Retinal fundus photograph.
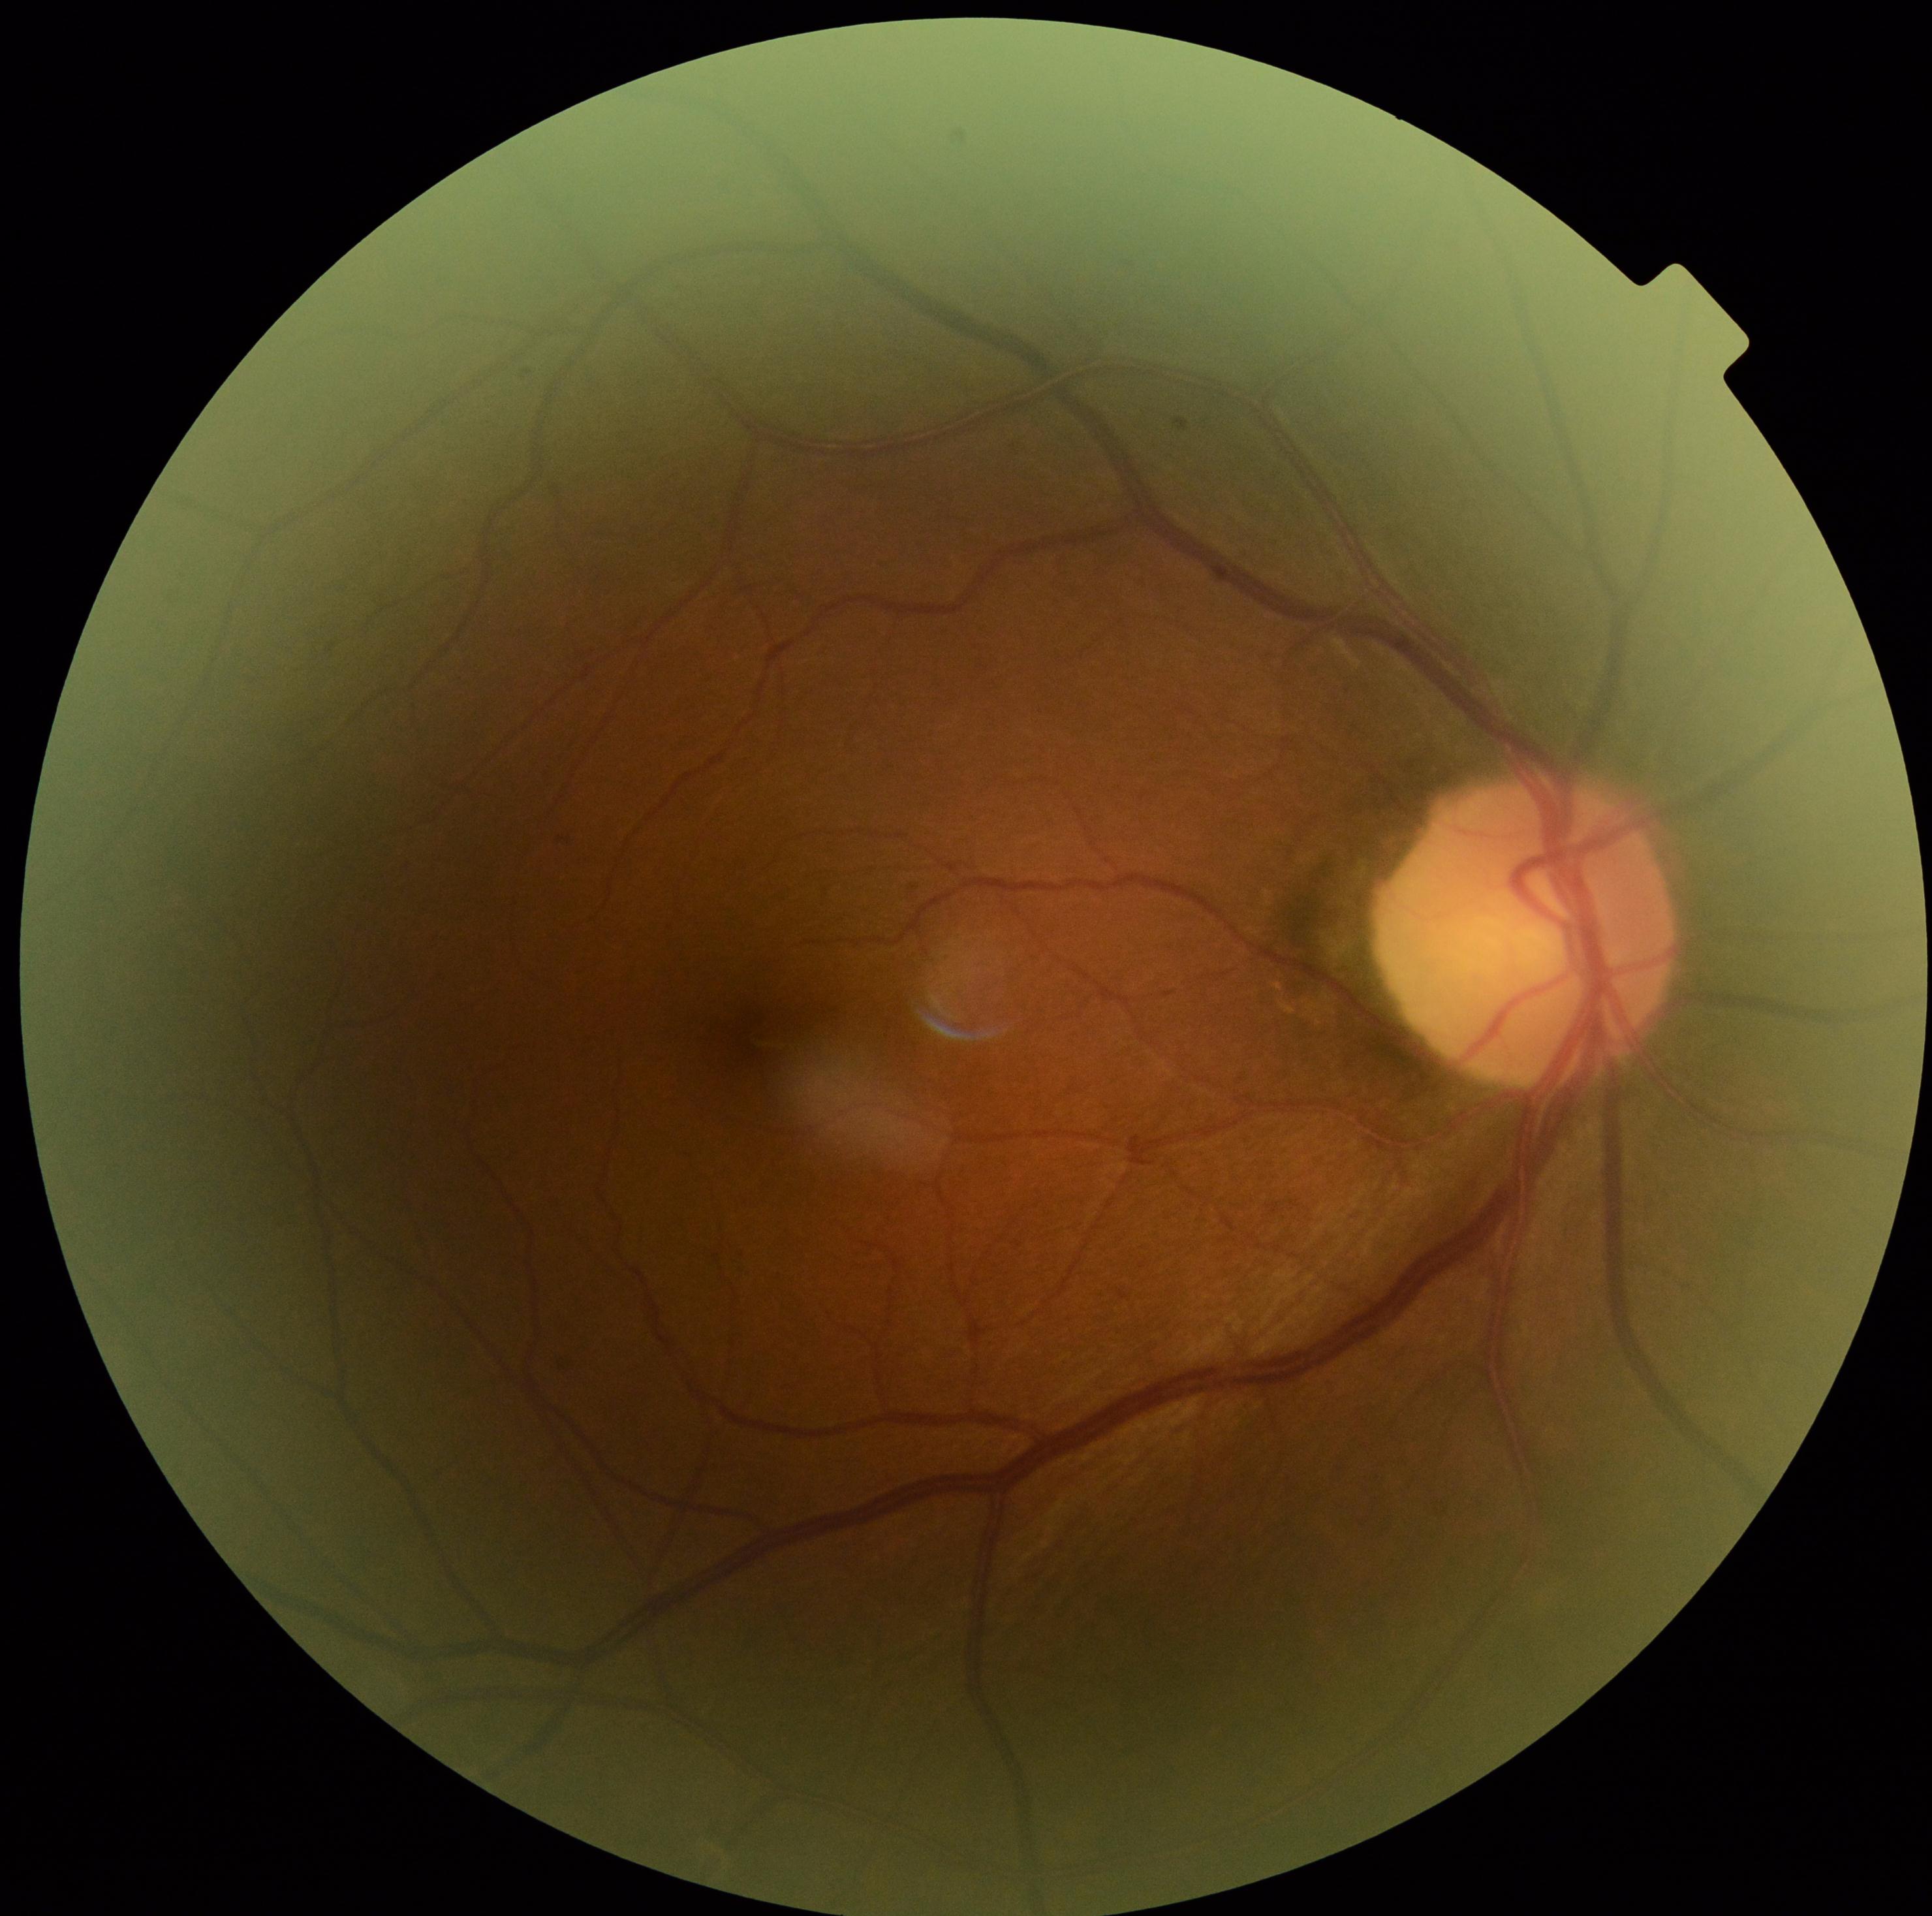
Findings:
* diabetic retinopathy (DR) — 0 — no visible signs of diabetic retinopathy
* DR impression — no DR findings